Clarity RetCam 3, 130° FOV. 640x480px. Wide-field fundus image from infant ROP screening — 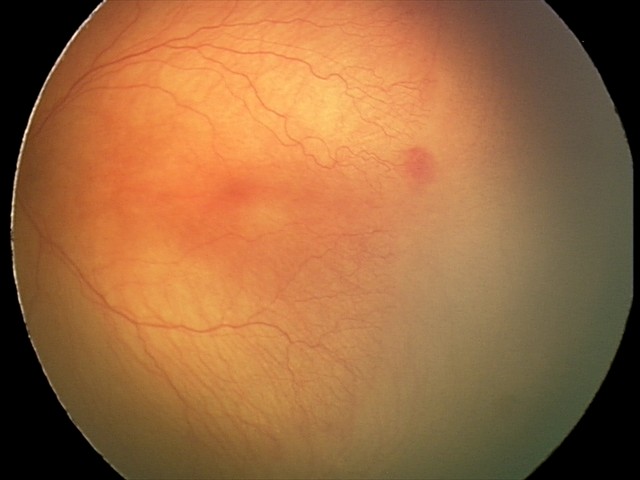 From an examination with diagnosis of aggressive retinopathy of prematurity (A-ROP). Plus disease present.